45 degree fundus photograph; graded on the modified Davis scale: 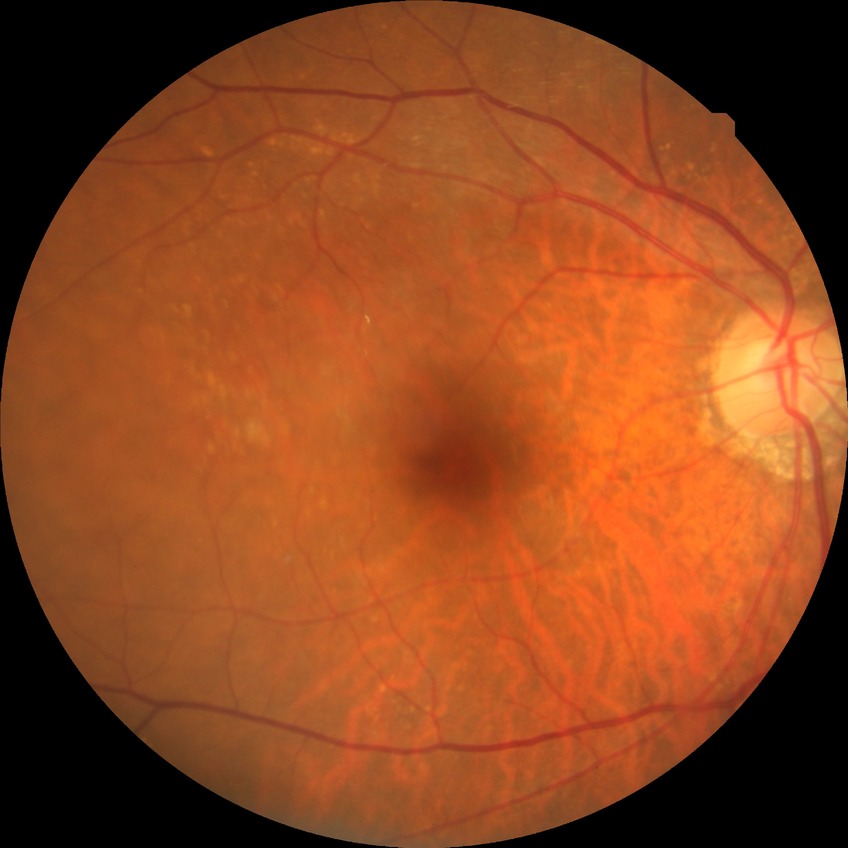
Modified Davis classification: no diabetic retinopathy.